Image size 1932x1916 · 45° FOV: 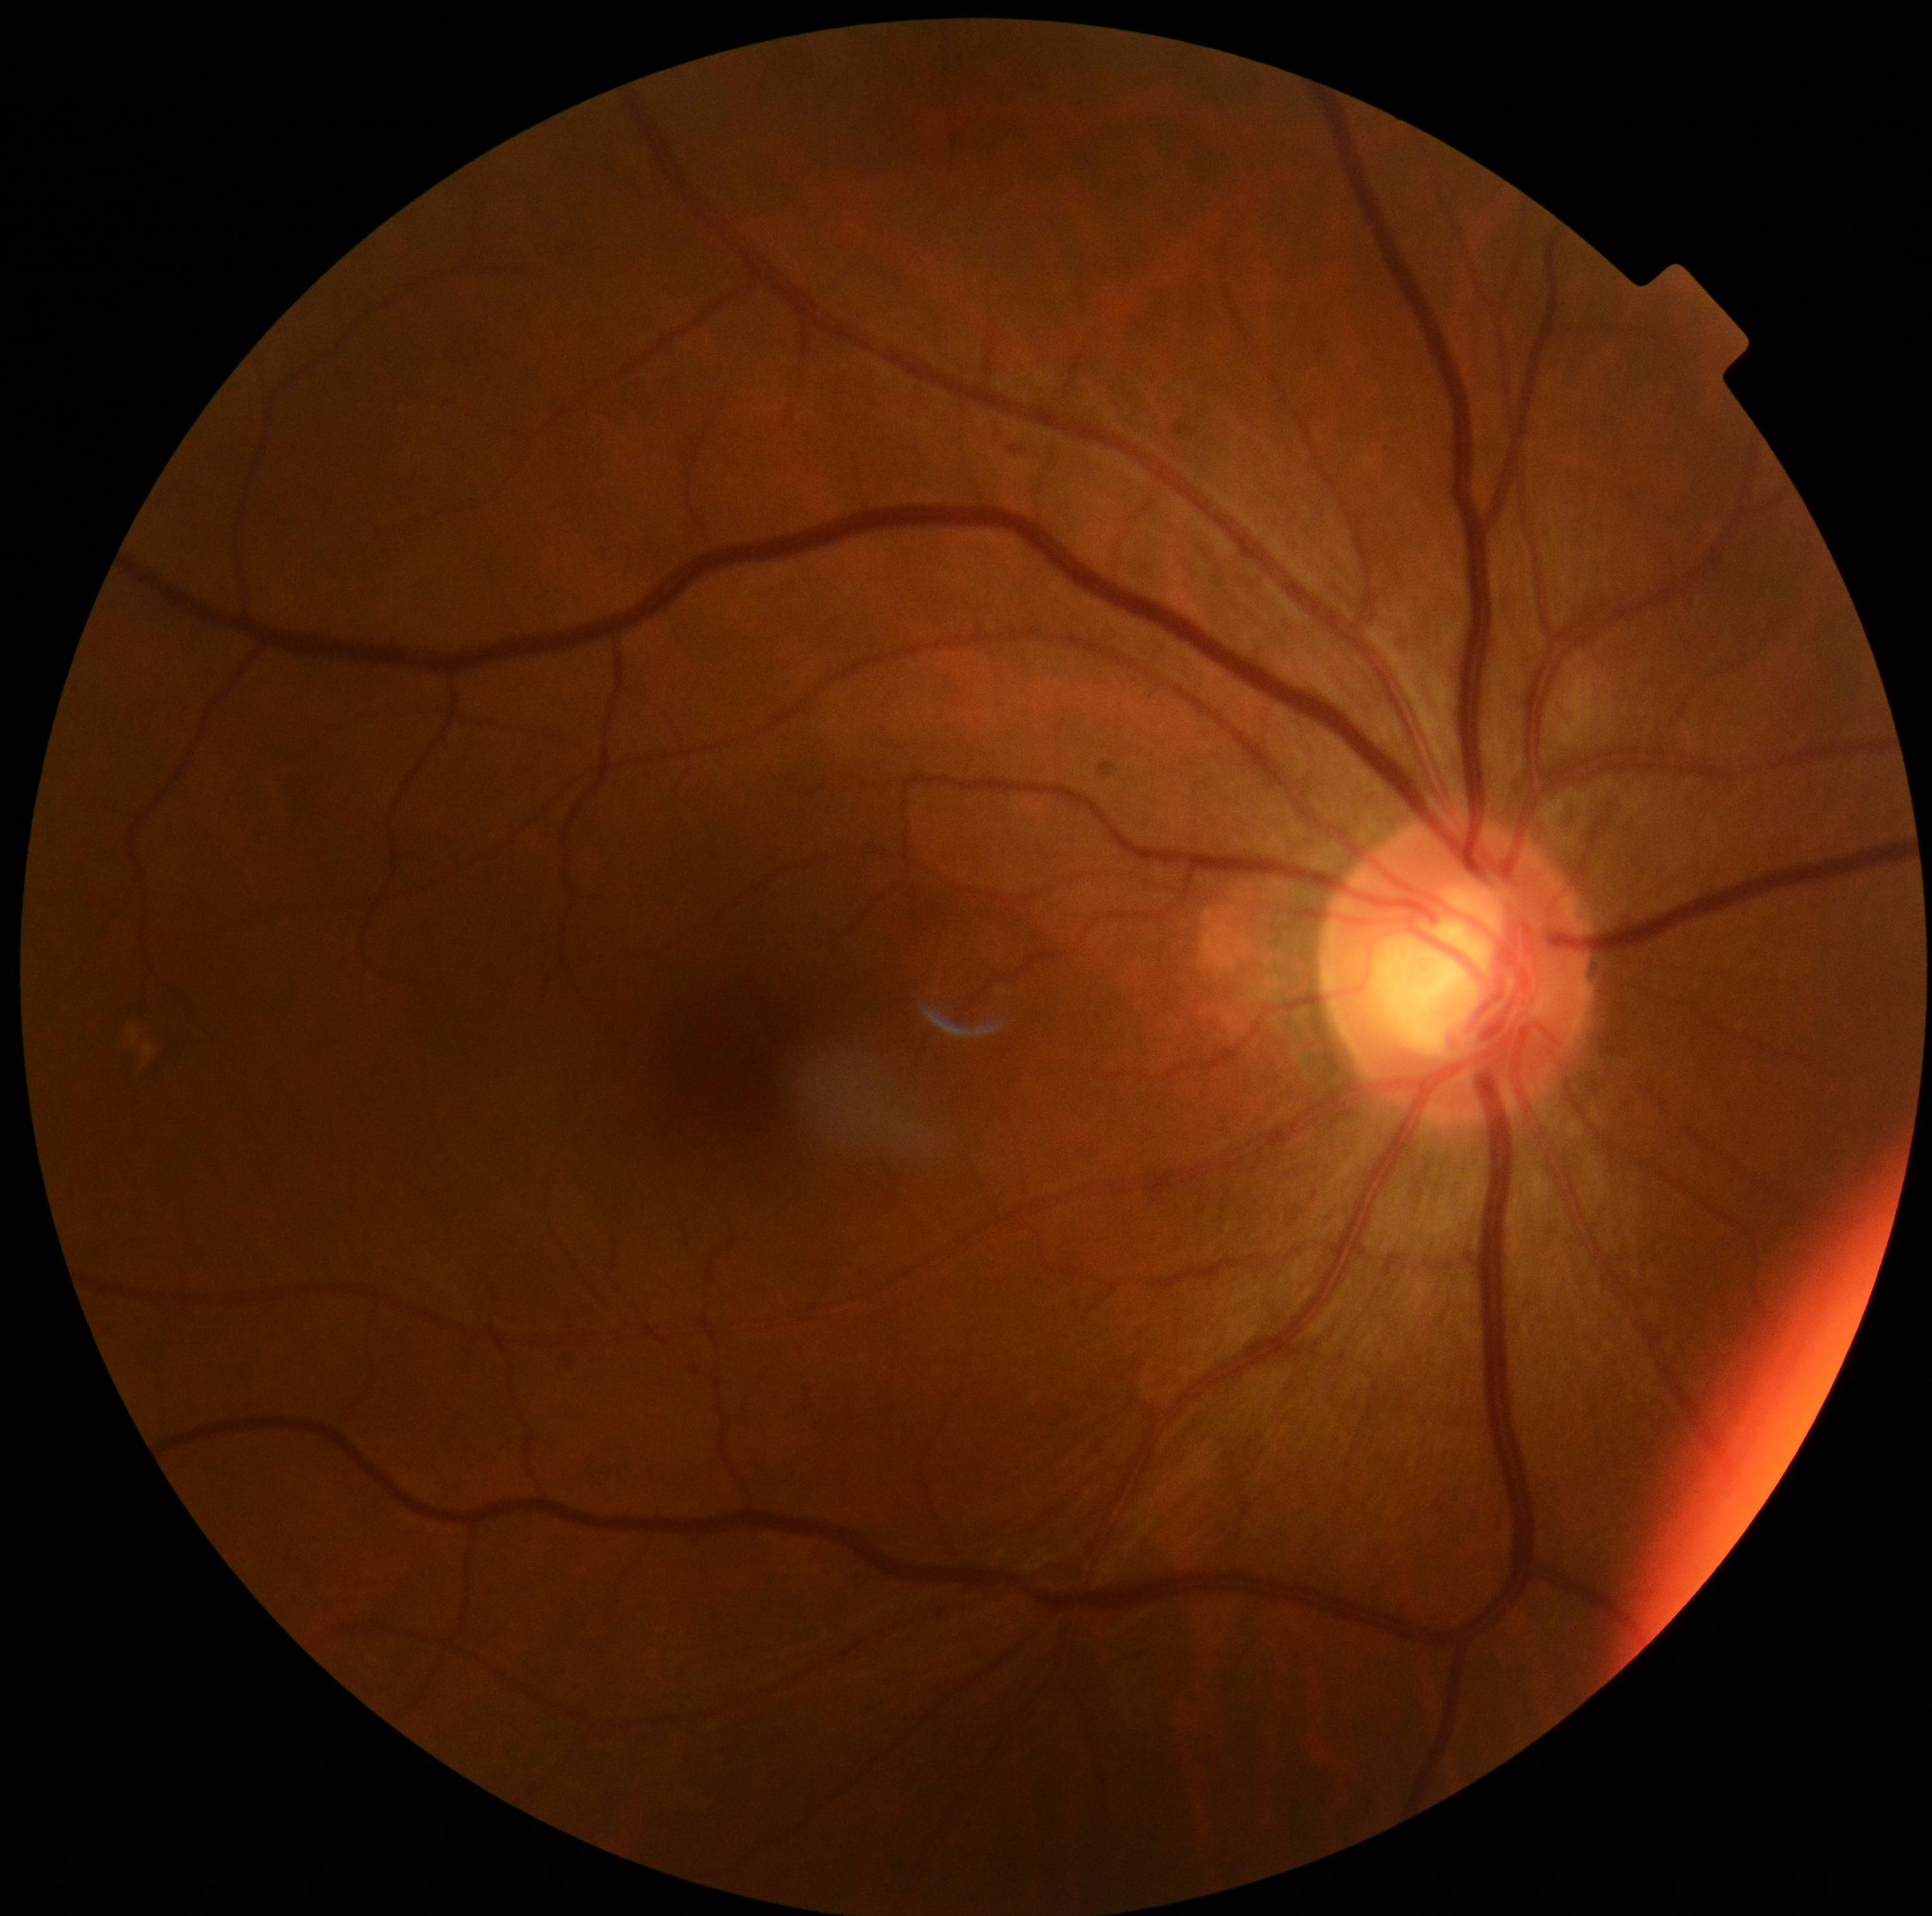 Annotations:
– DR severity — grade 0